2089x1764:
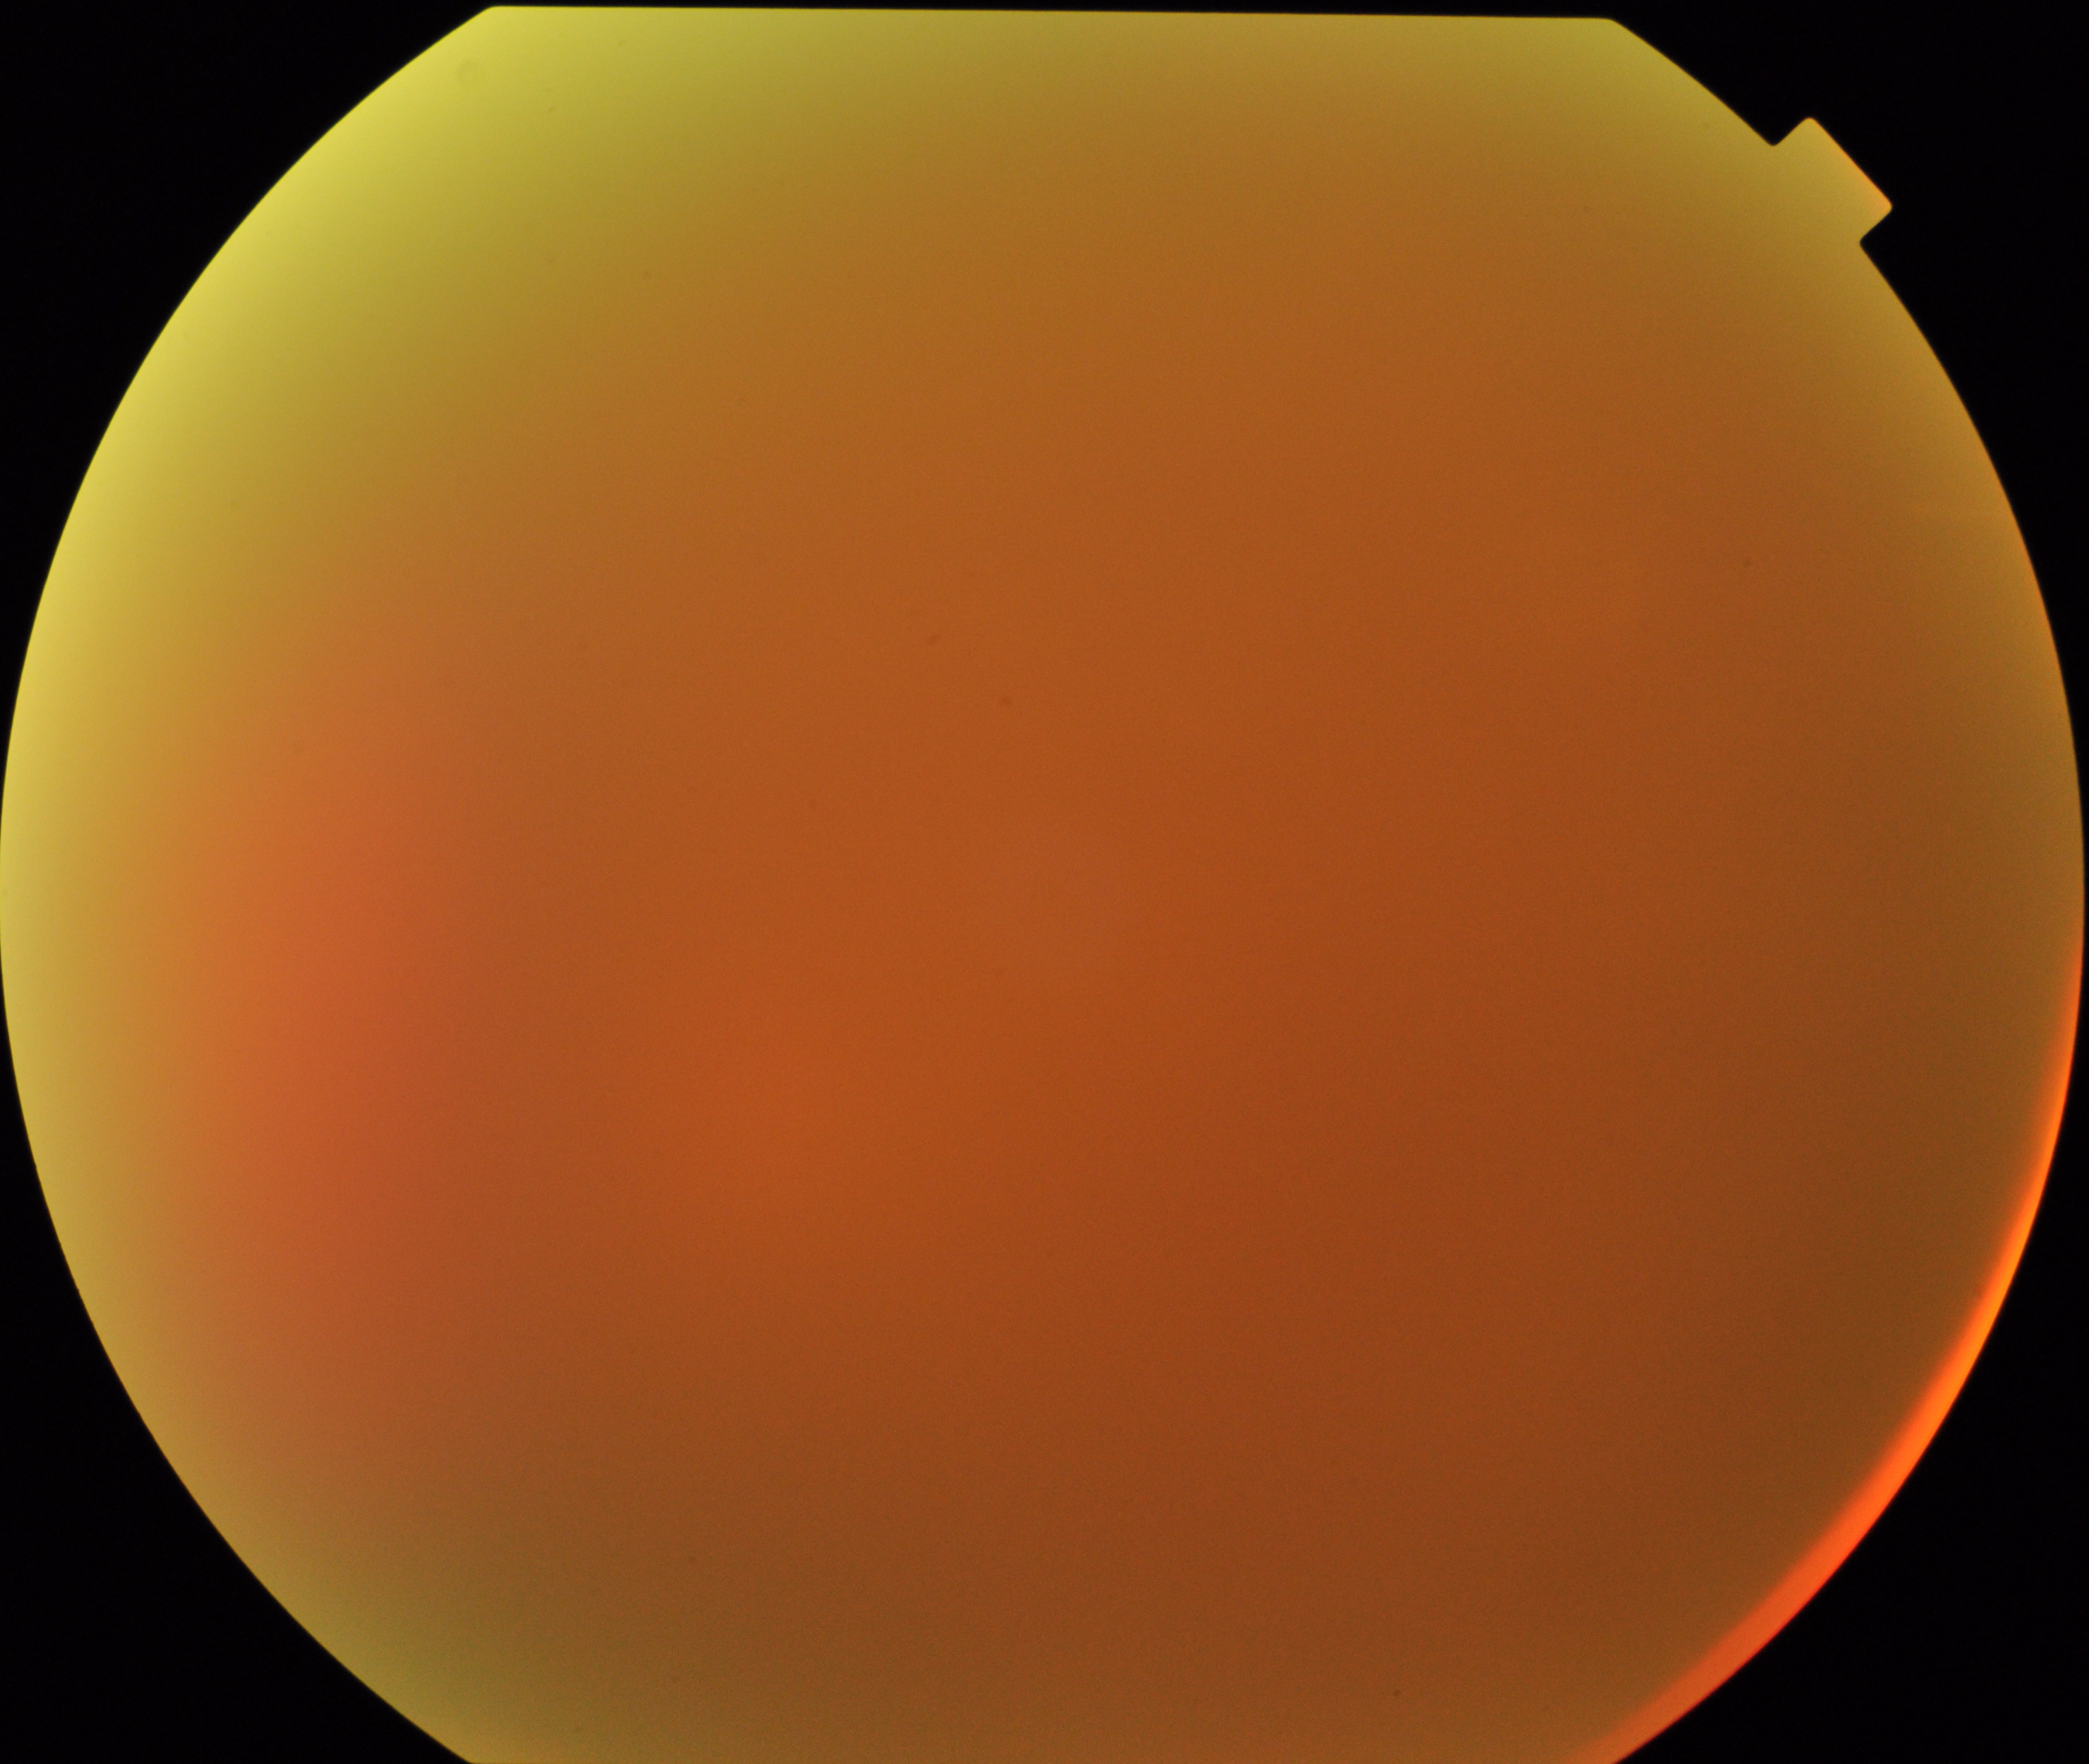
Significantly degraded image quality with obscured retinal detail. Proliferative diabetic retinopathy not identified in the visible portion.